Modified Davis classification — 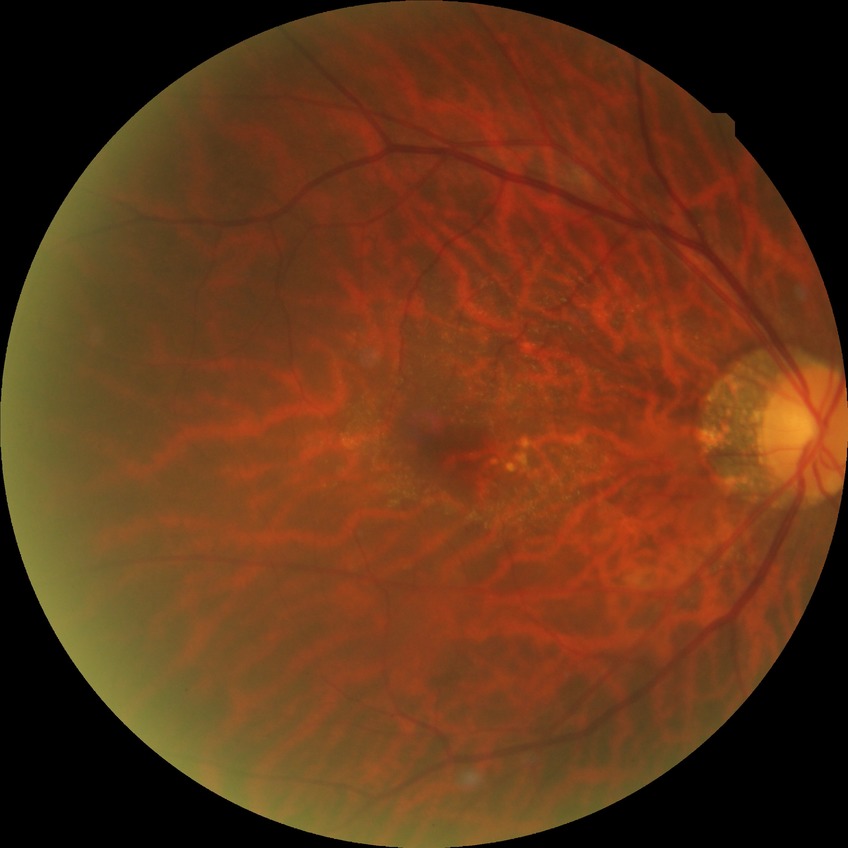

Davis DR grade is SDR.